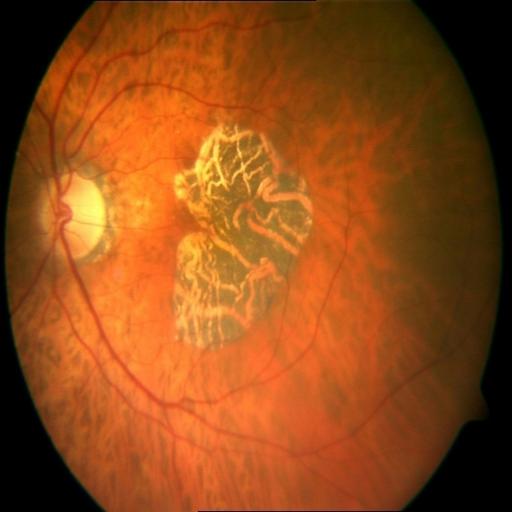

Diagnoses: macular scar (MS).